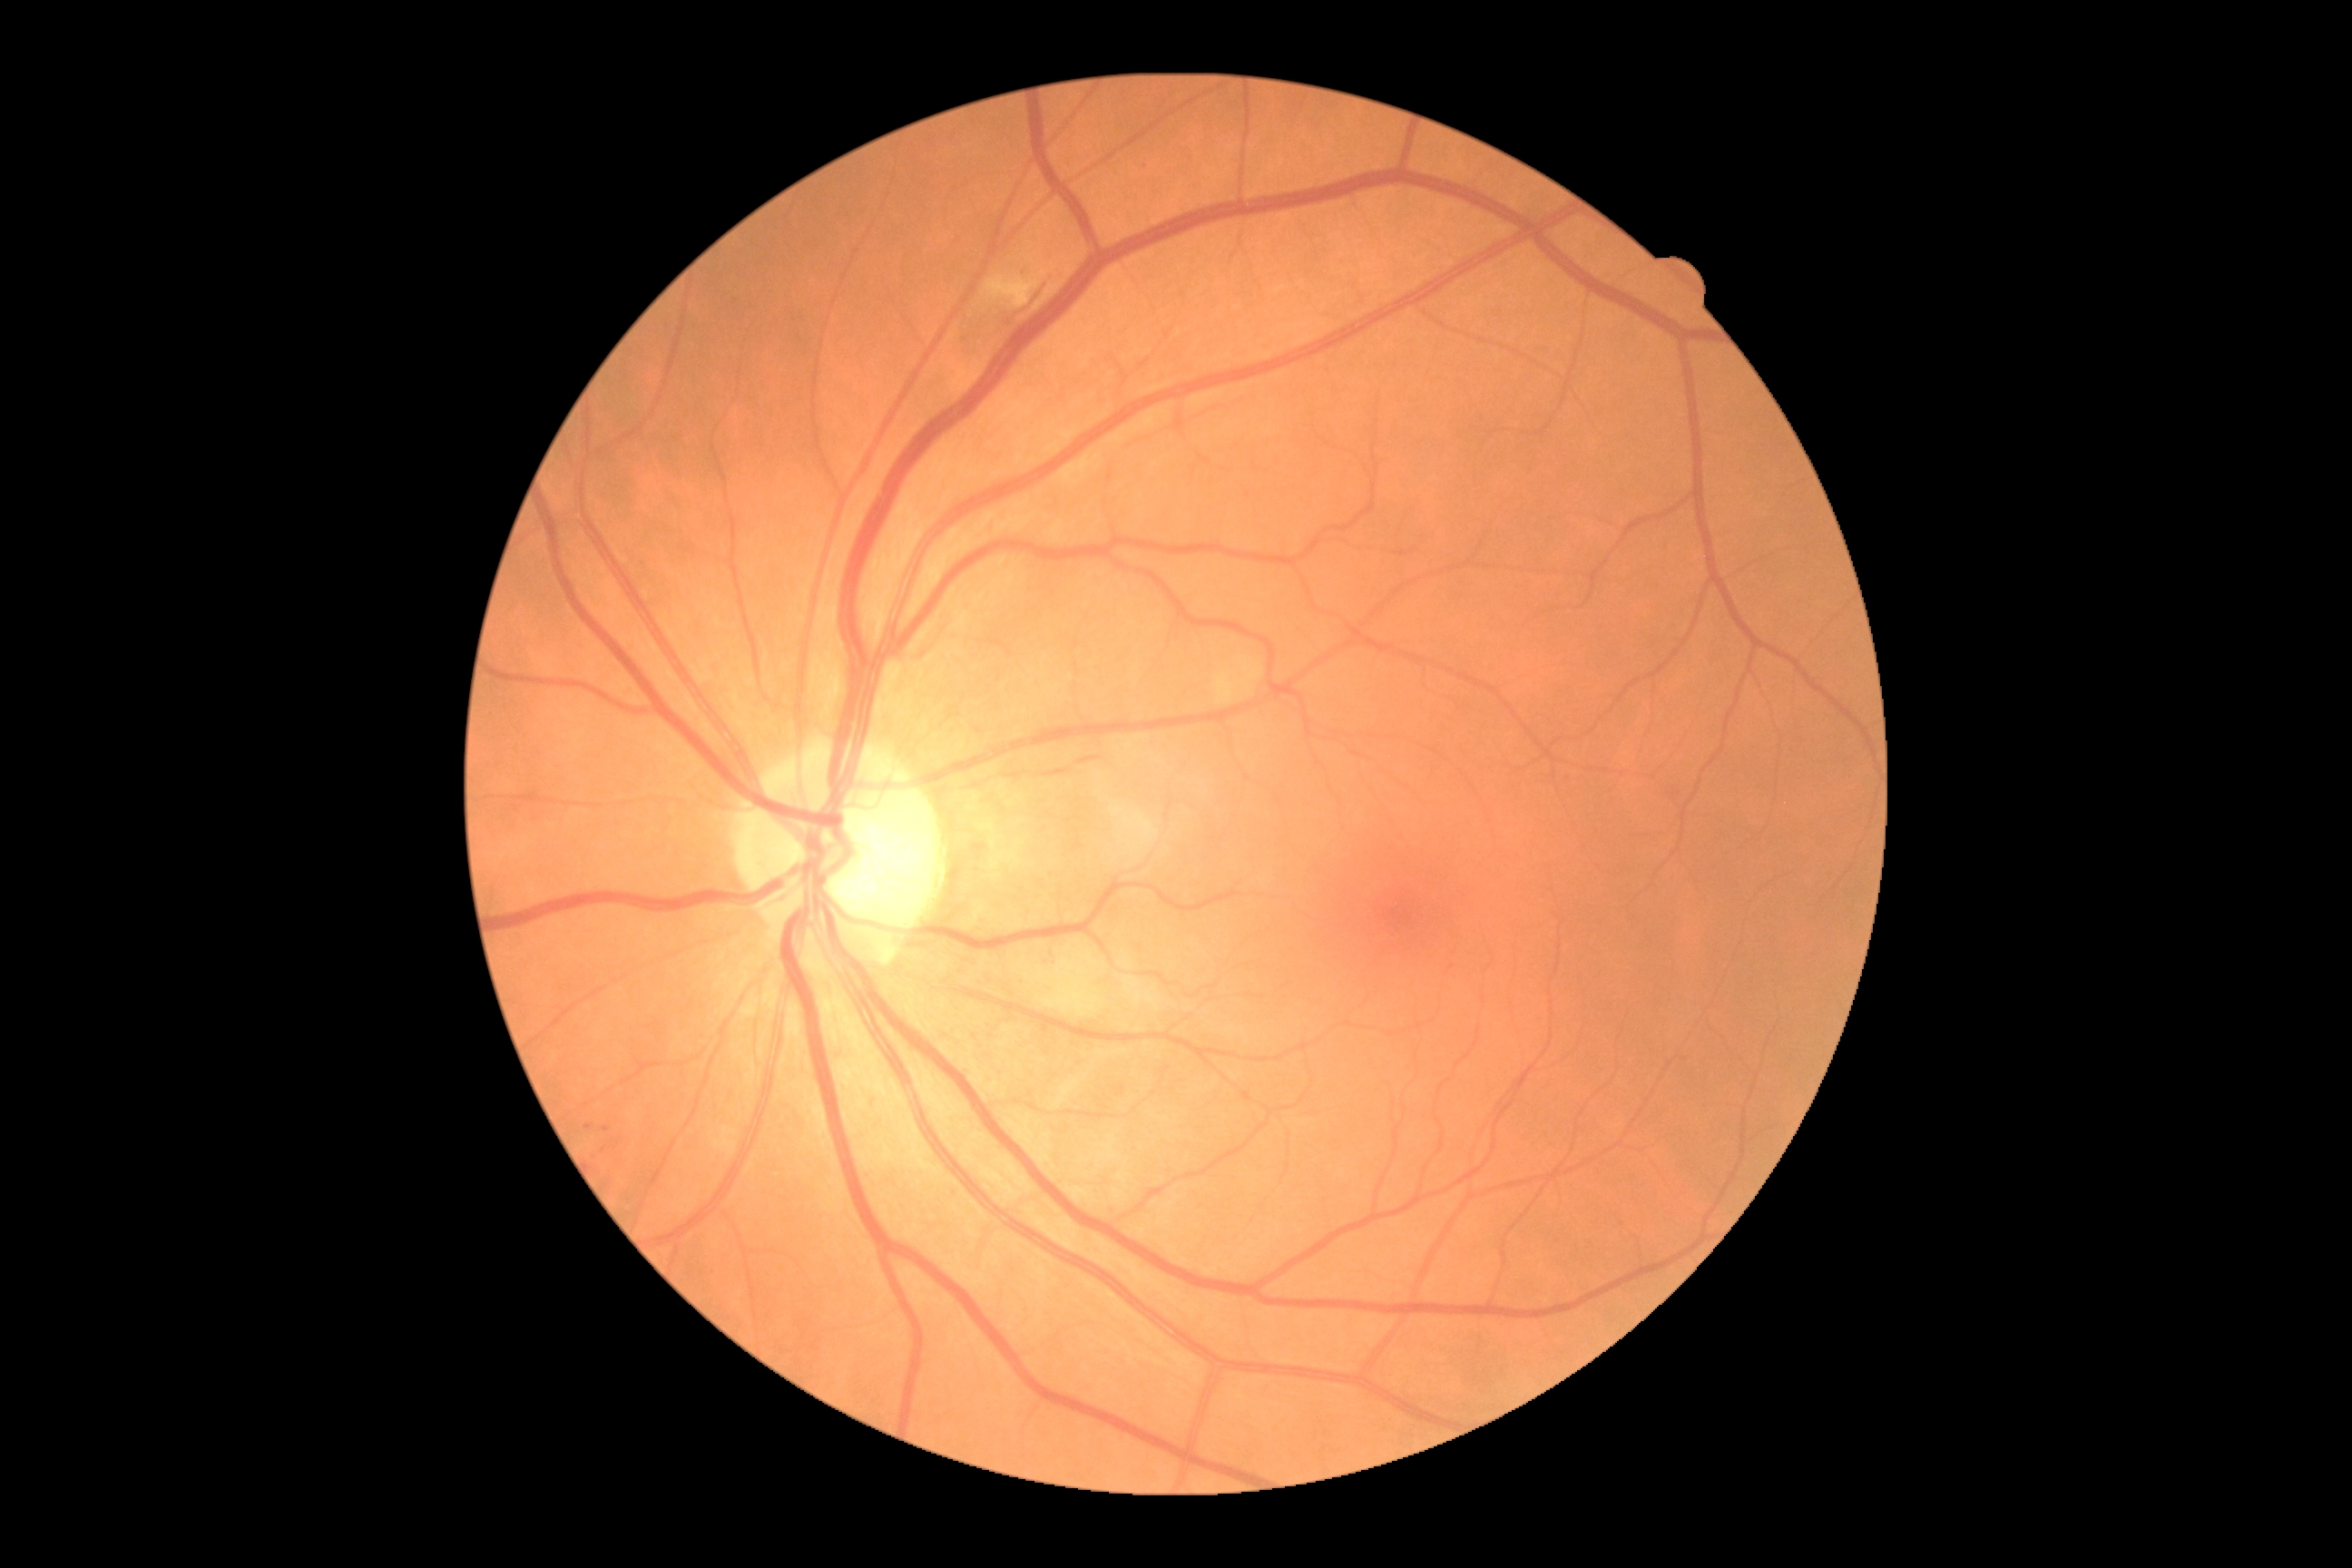 DR stage: 2.